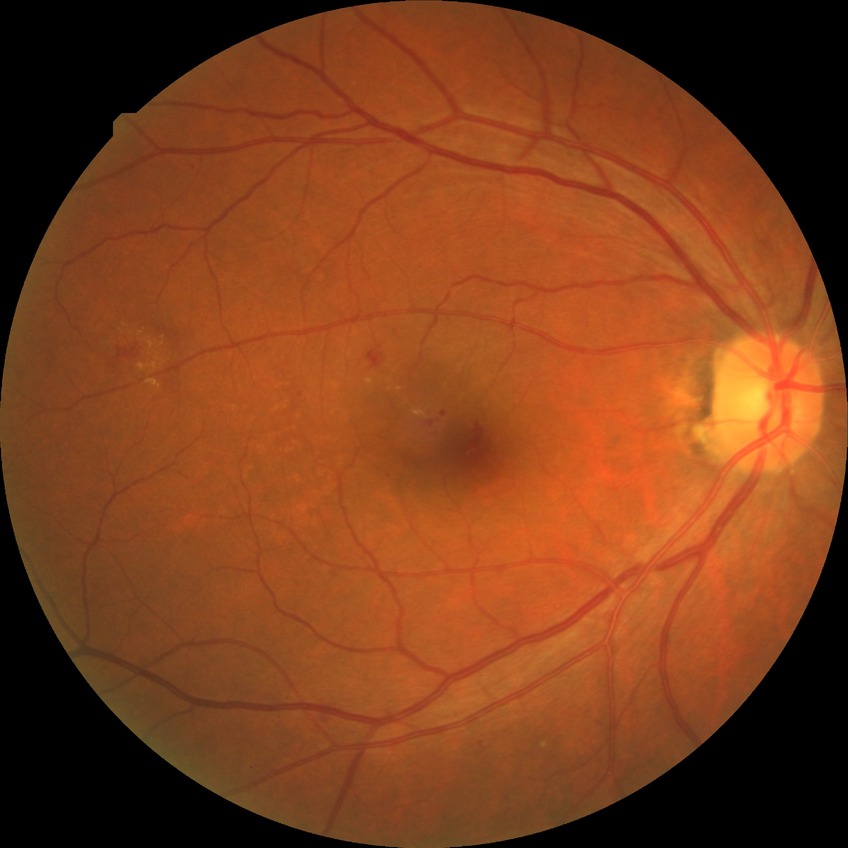
Diabetic retinopathy (DR): SDR (simple diabetic retinopathy).